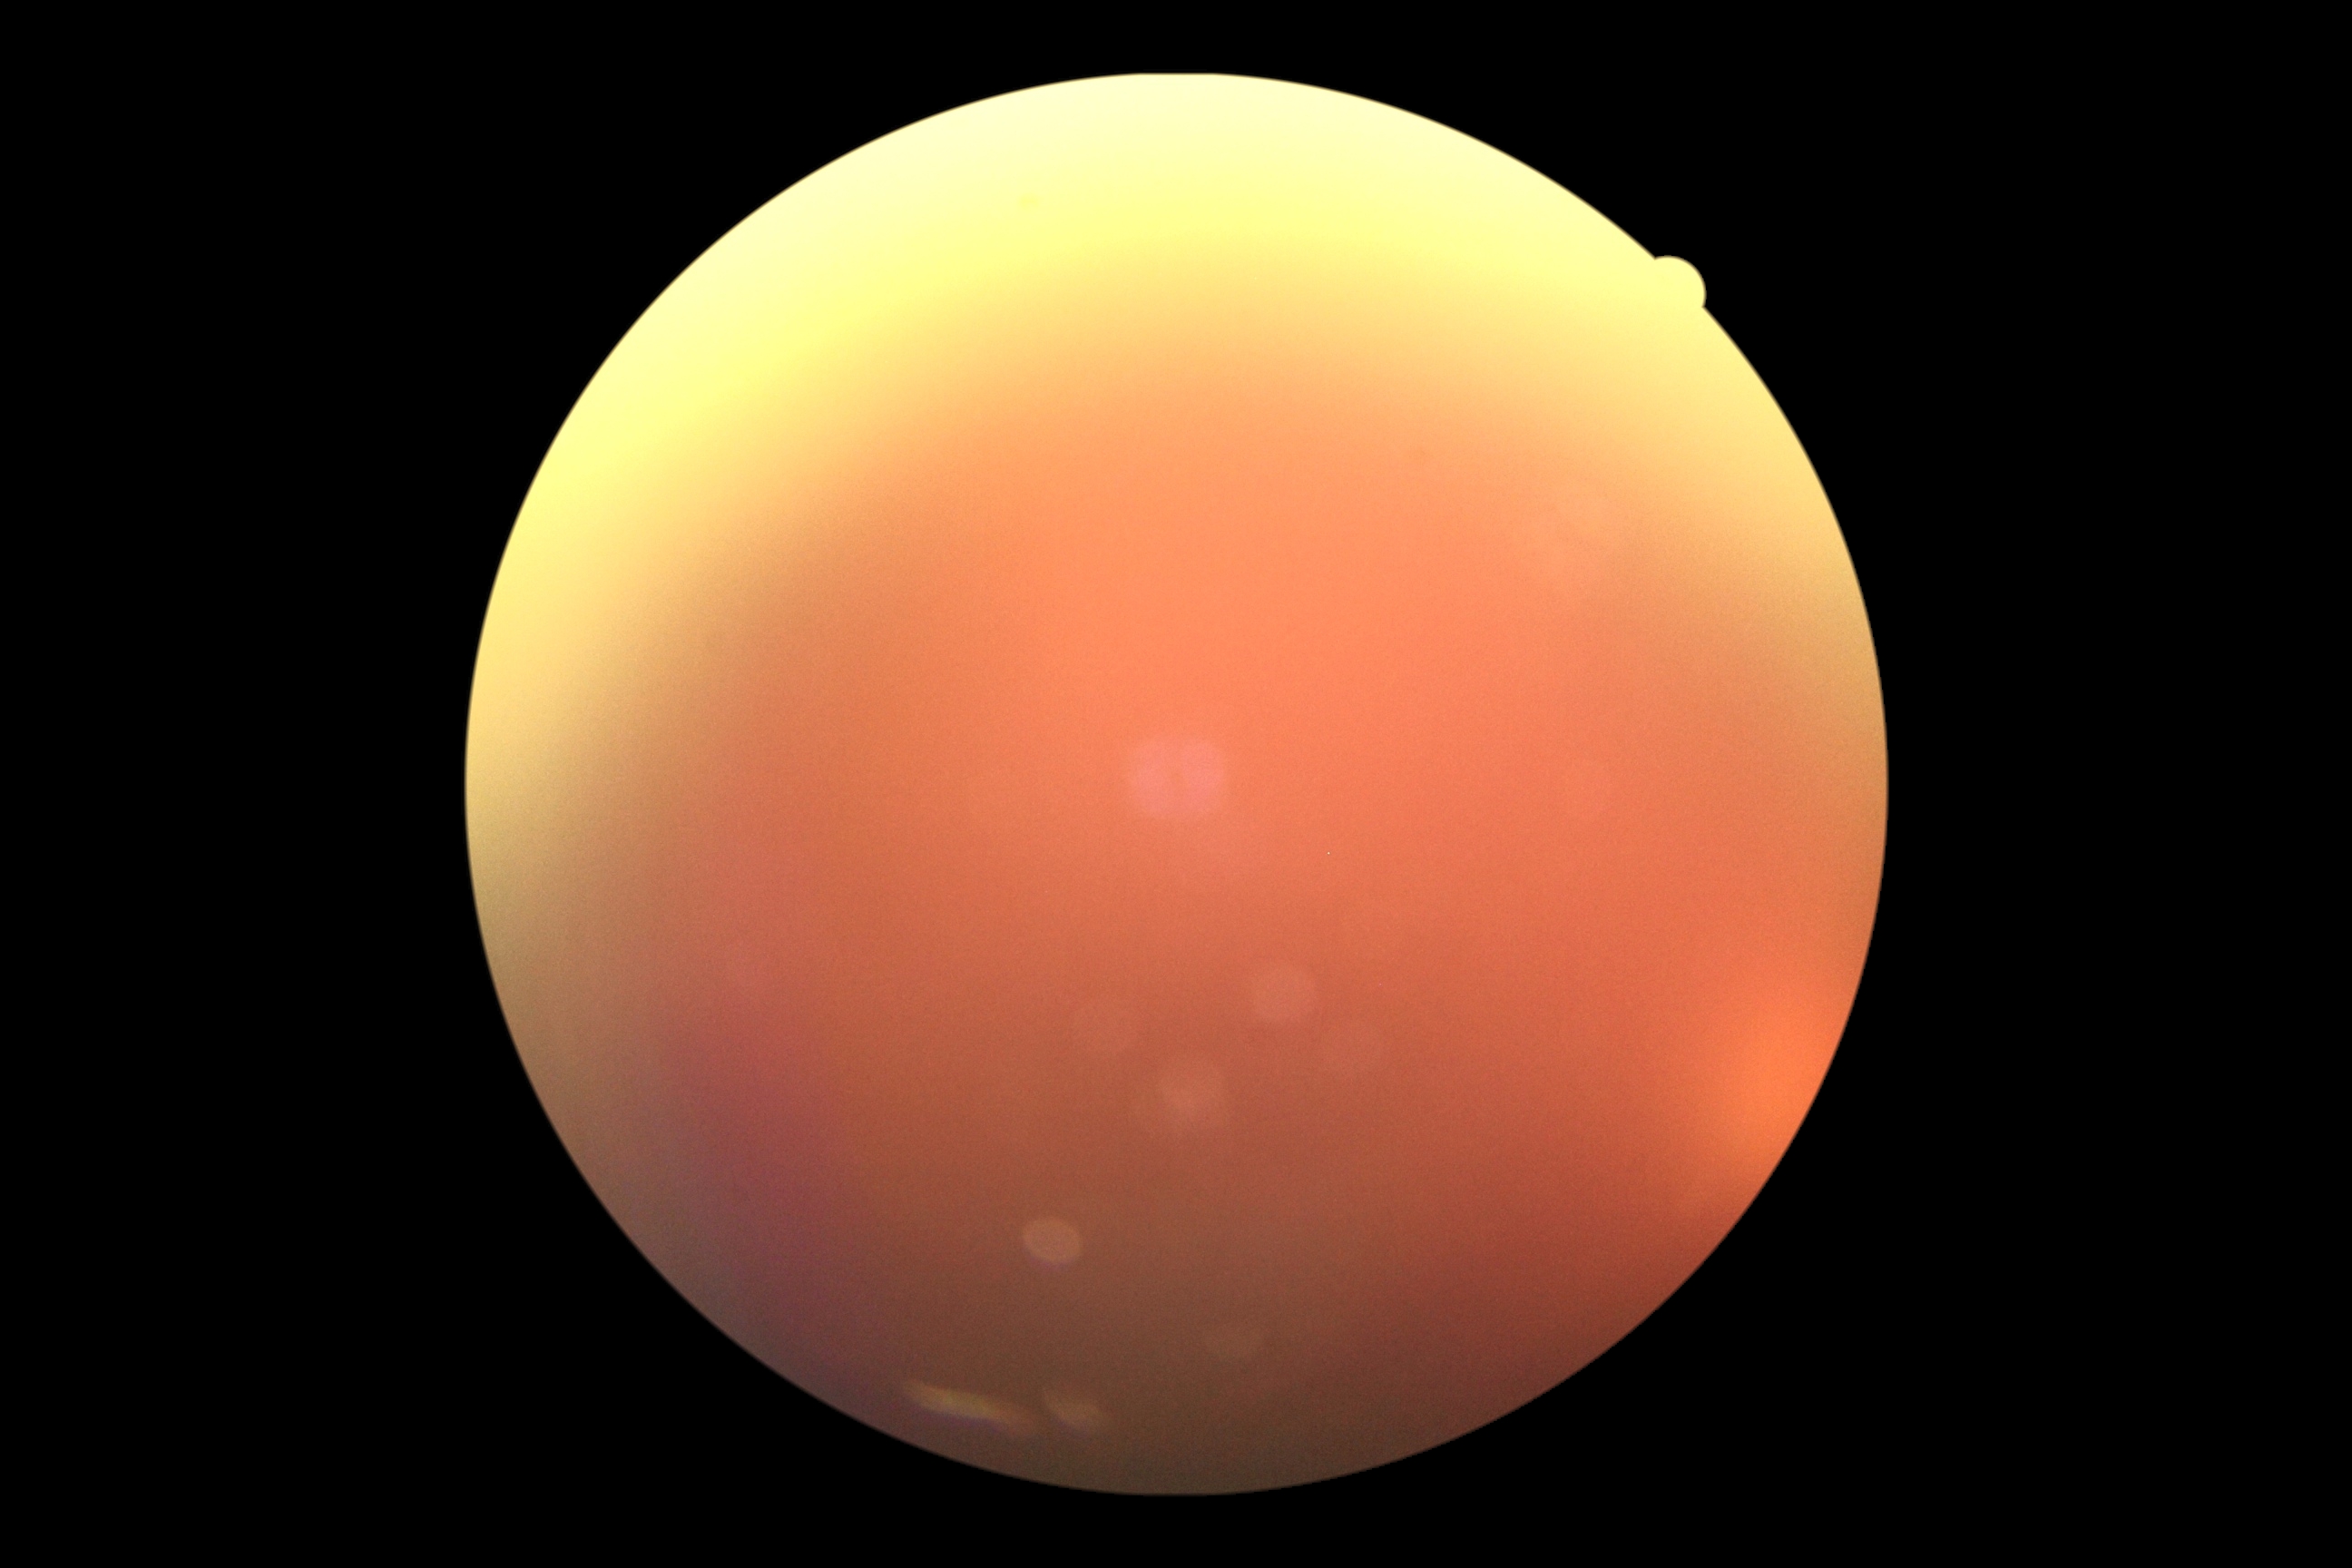 Diabetic retinopathy (DR): ungradable.